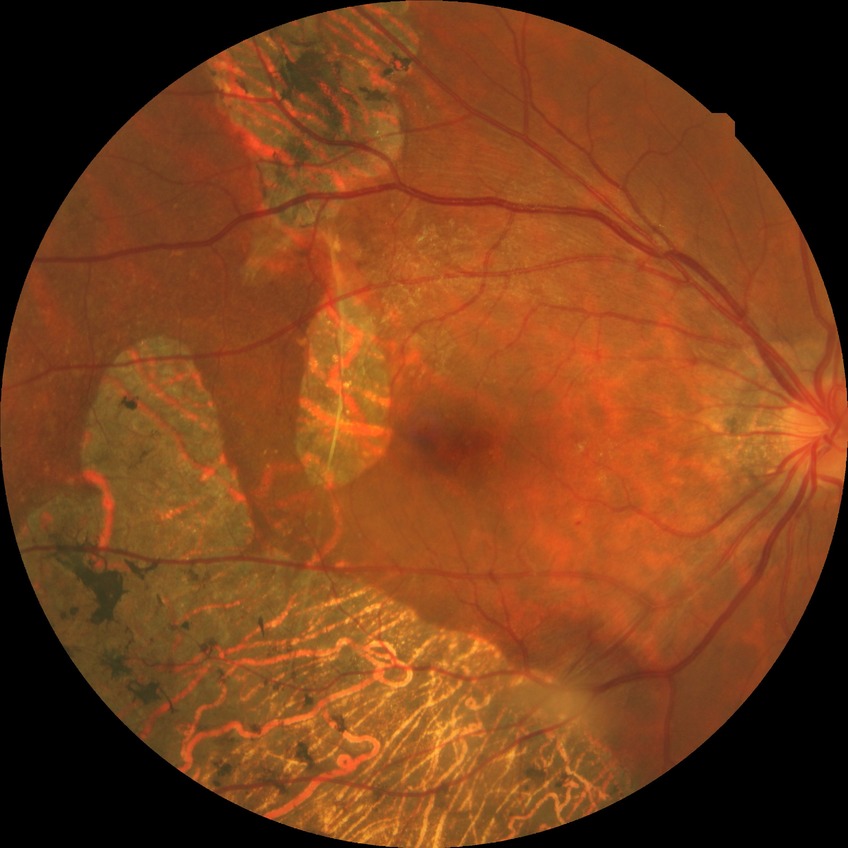
retinopathy grade: simple diabetic retinopathy.